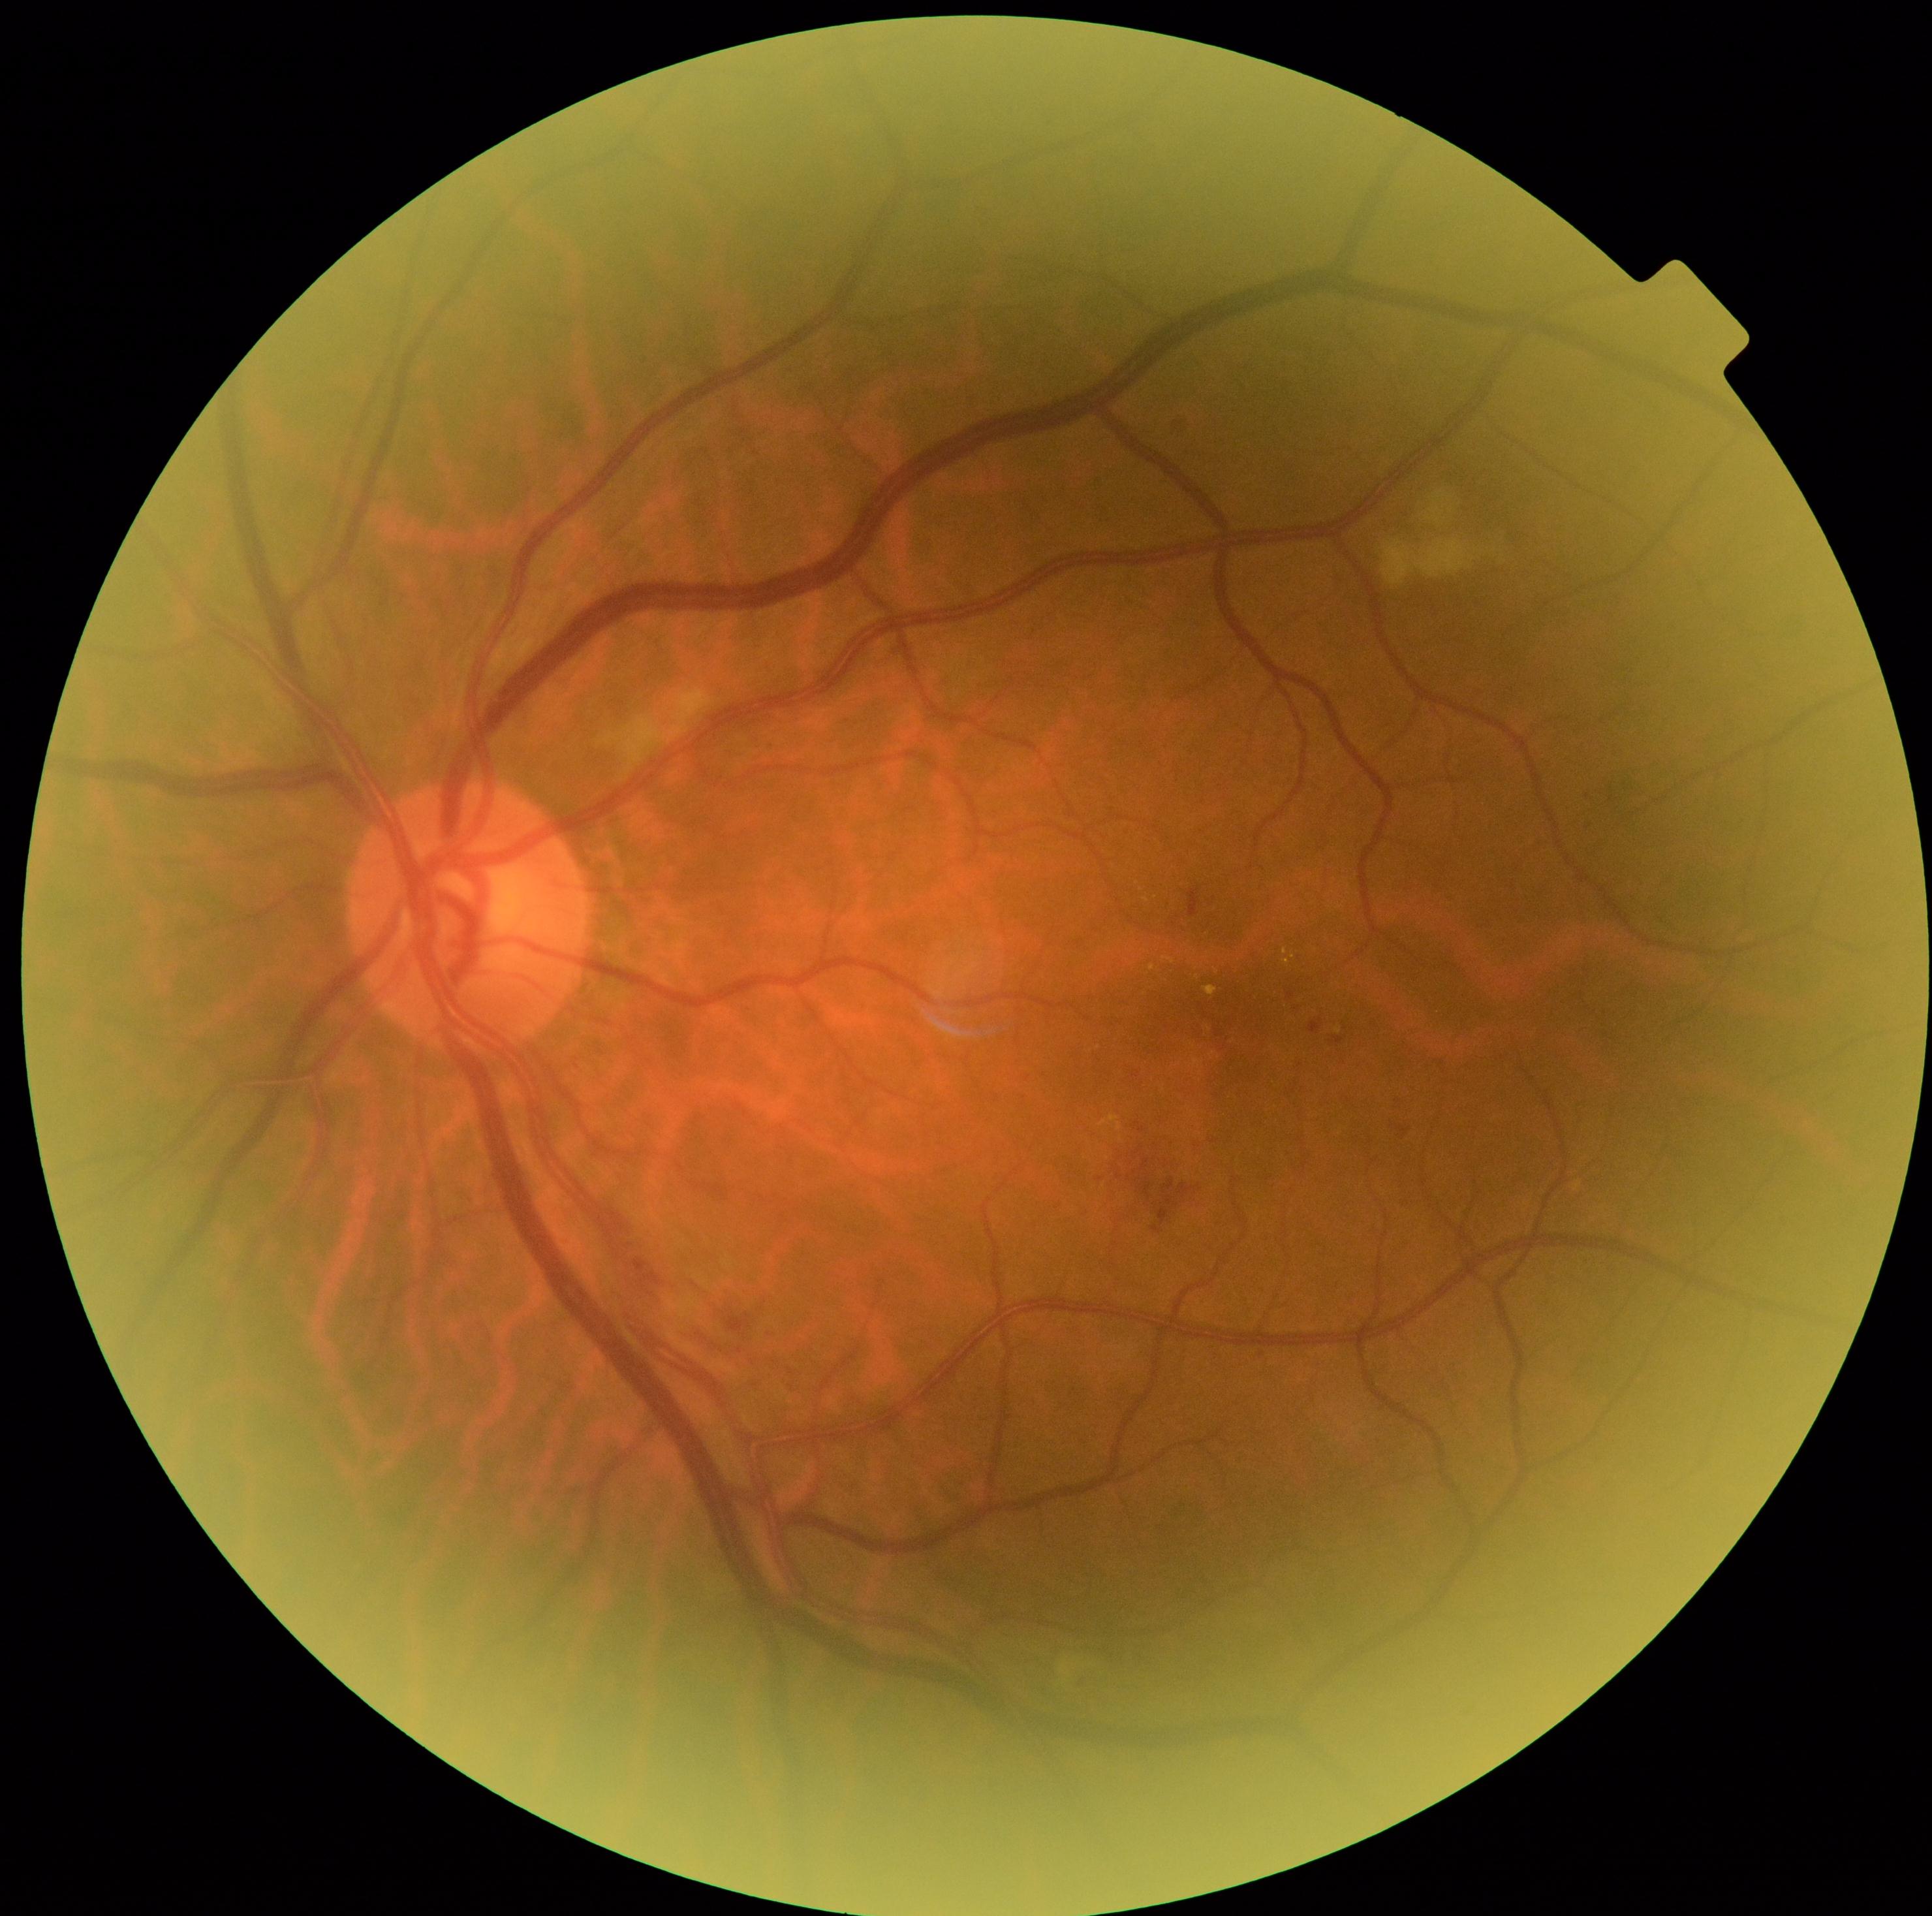

  dr_grade: moderate non-proliferative diabetic retinopathy (grade 2)